Retinal fundus photograph, Remidio FOP fundus camera, 1659 by 2212 pixels — 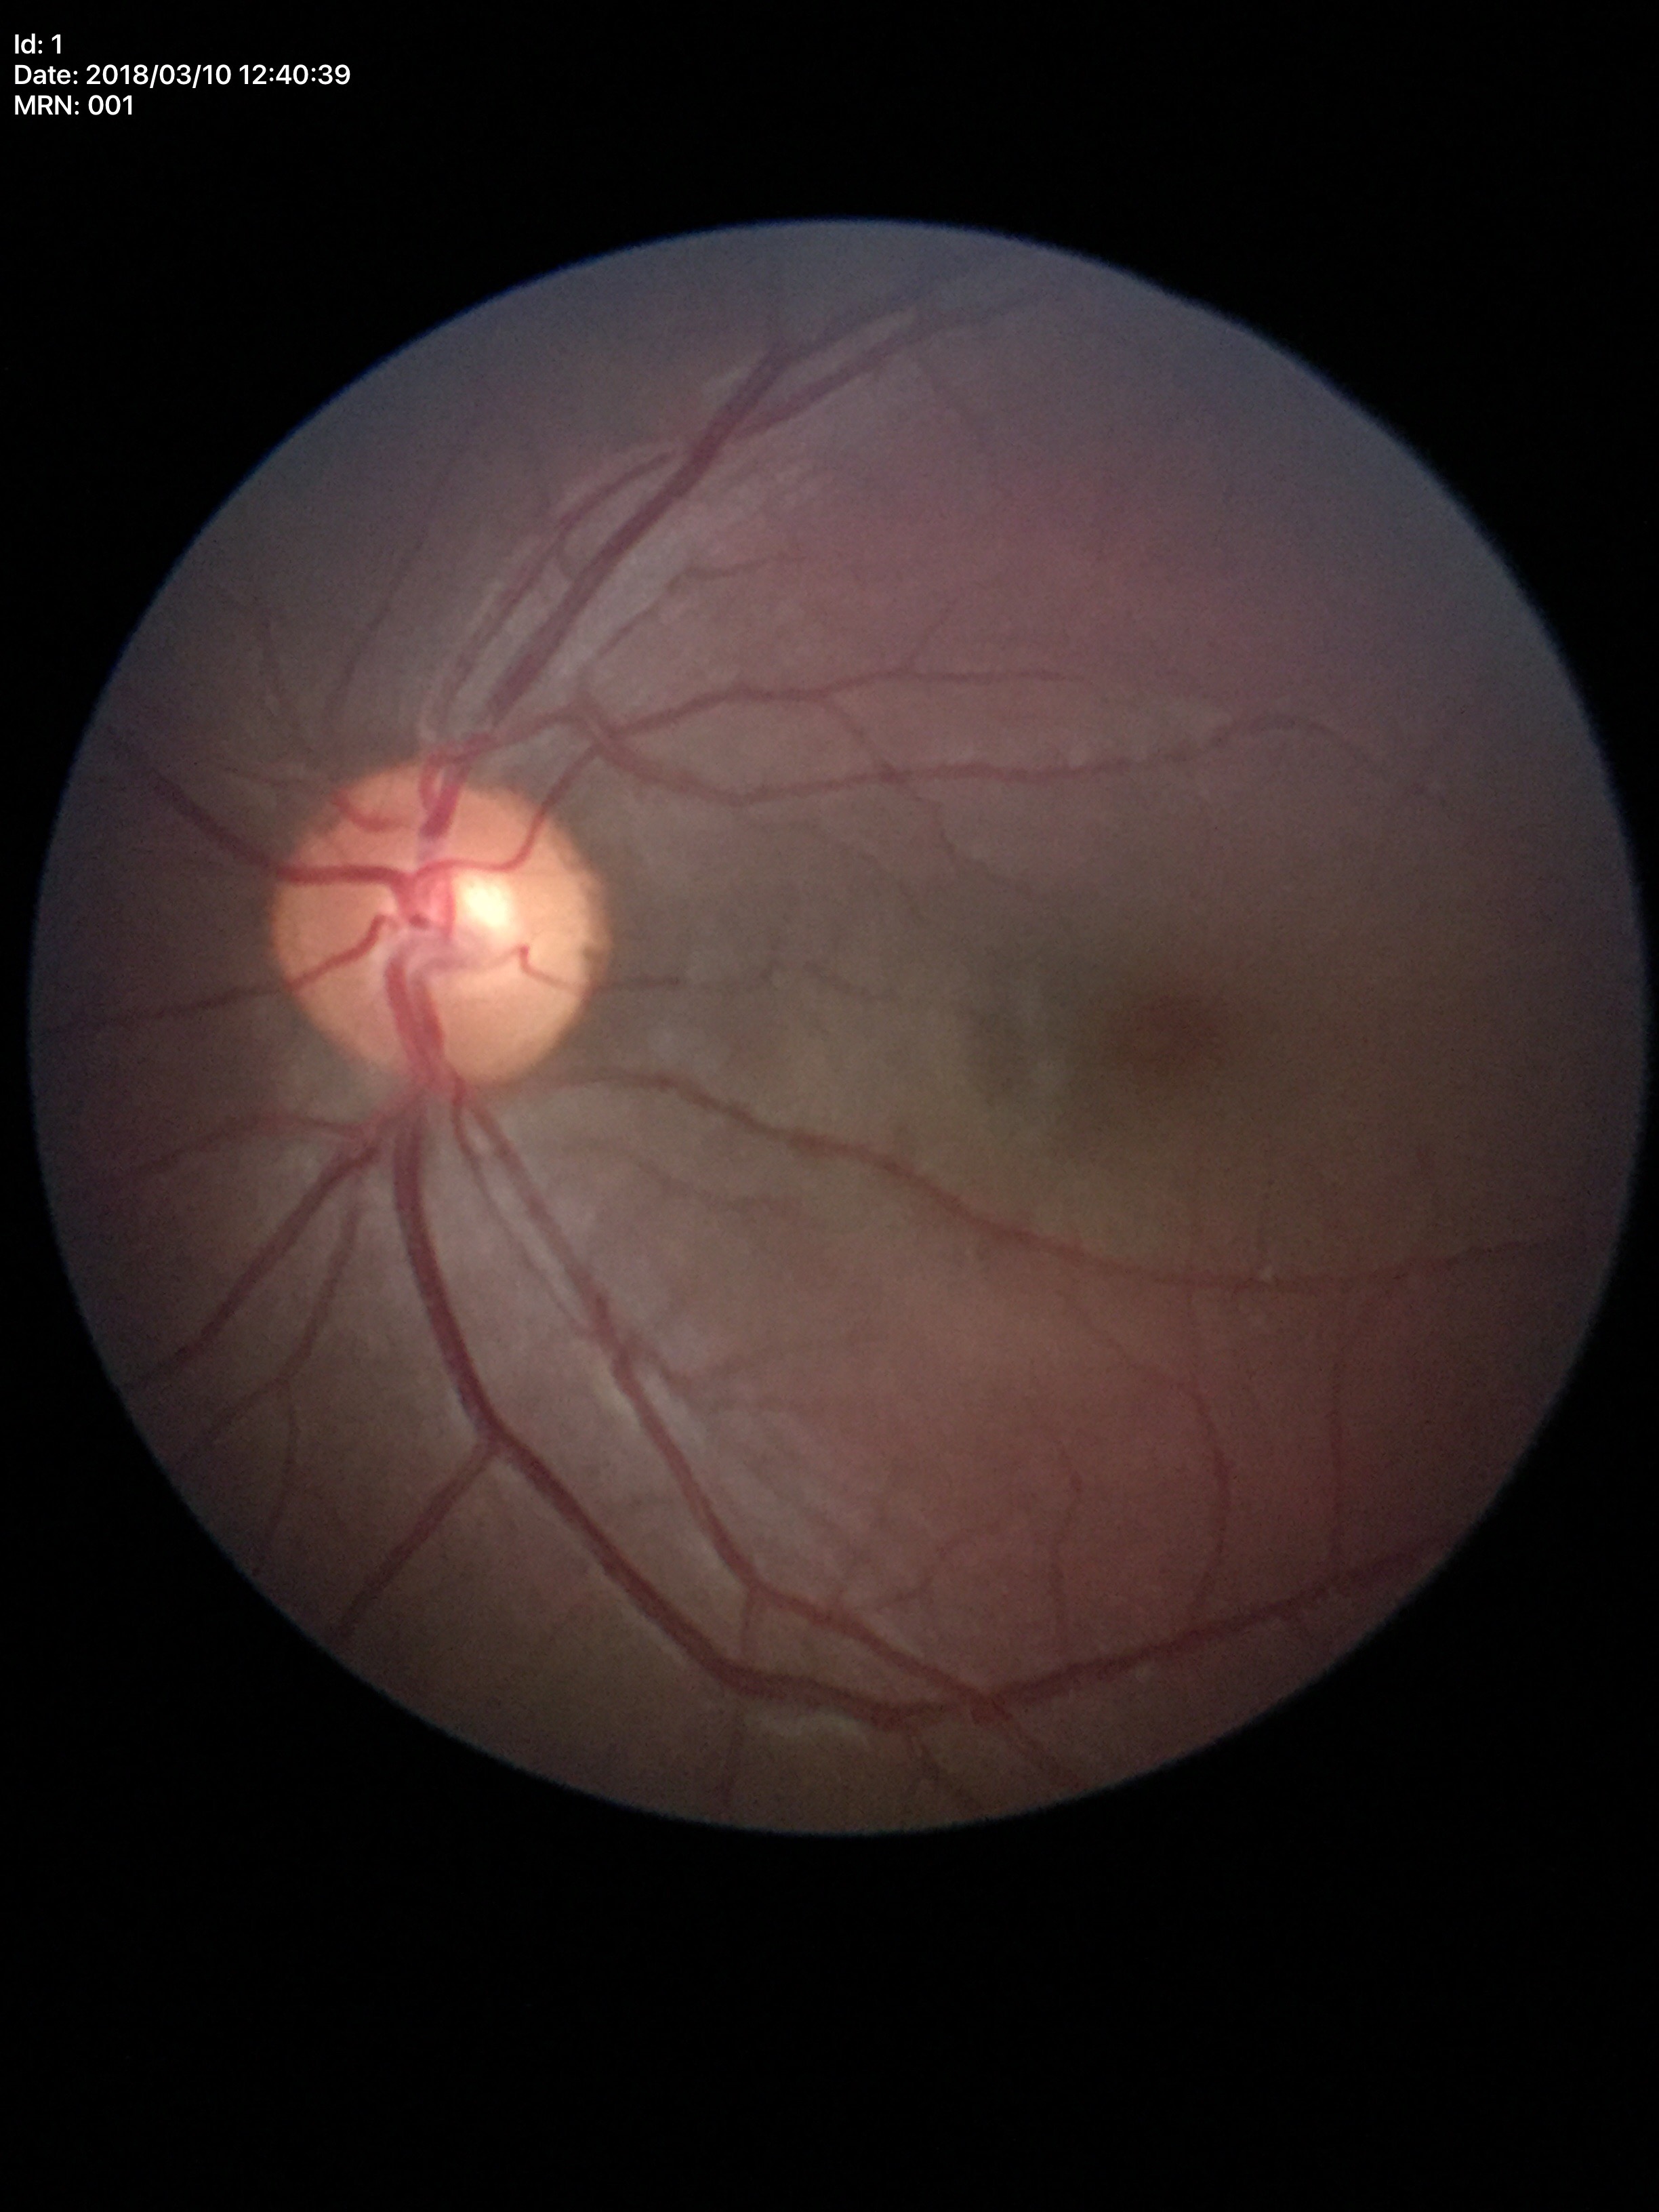   glaucoma_decision: no suspicious findings
  vcdr: 0.45